Acquired with a NIDEK AFC-230. No pharmacologic dilation:
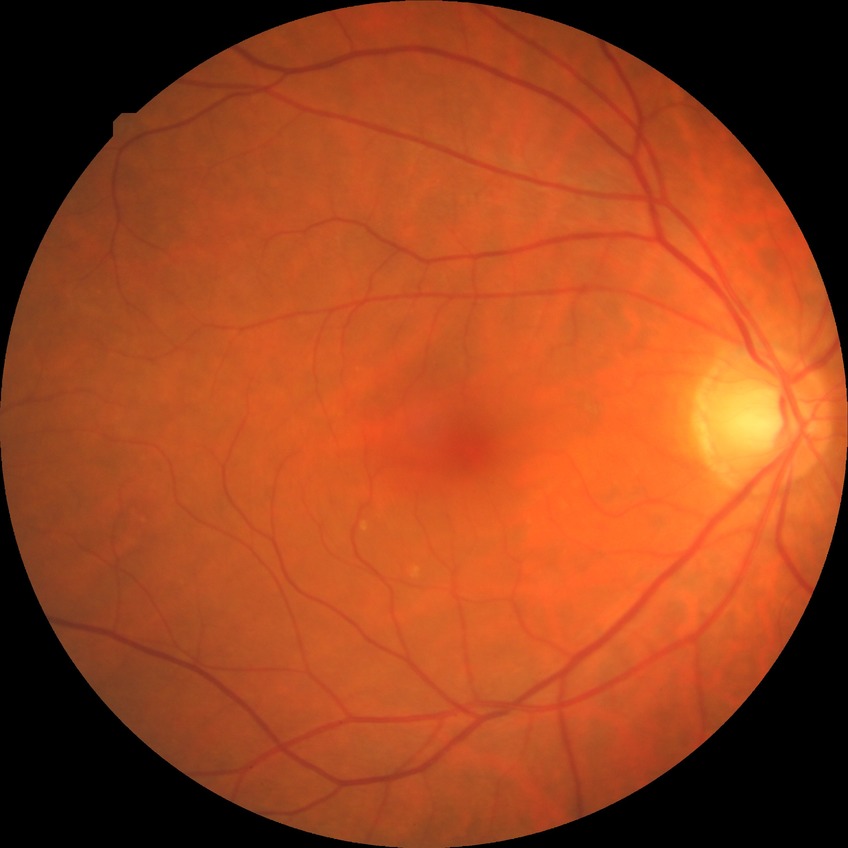 modified Davis grading=no diabetic retinopathy.